1960 x 1897 pixels.
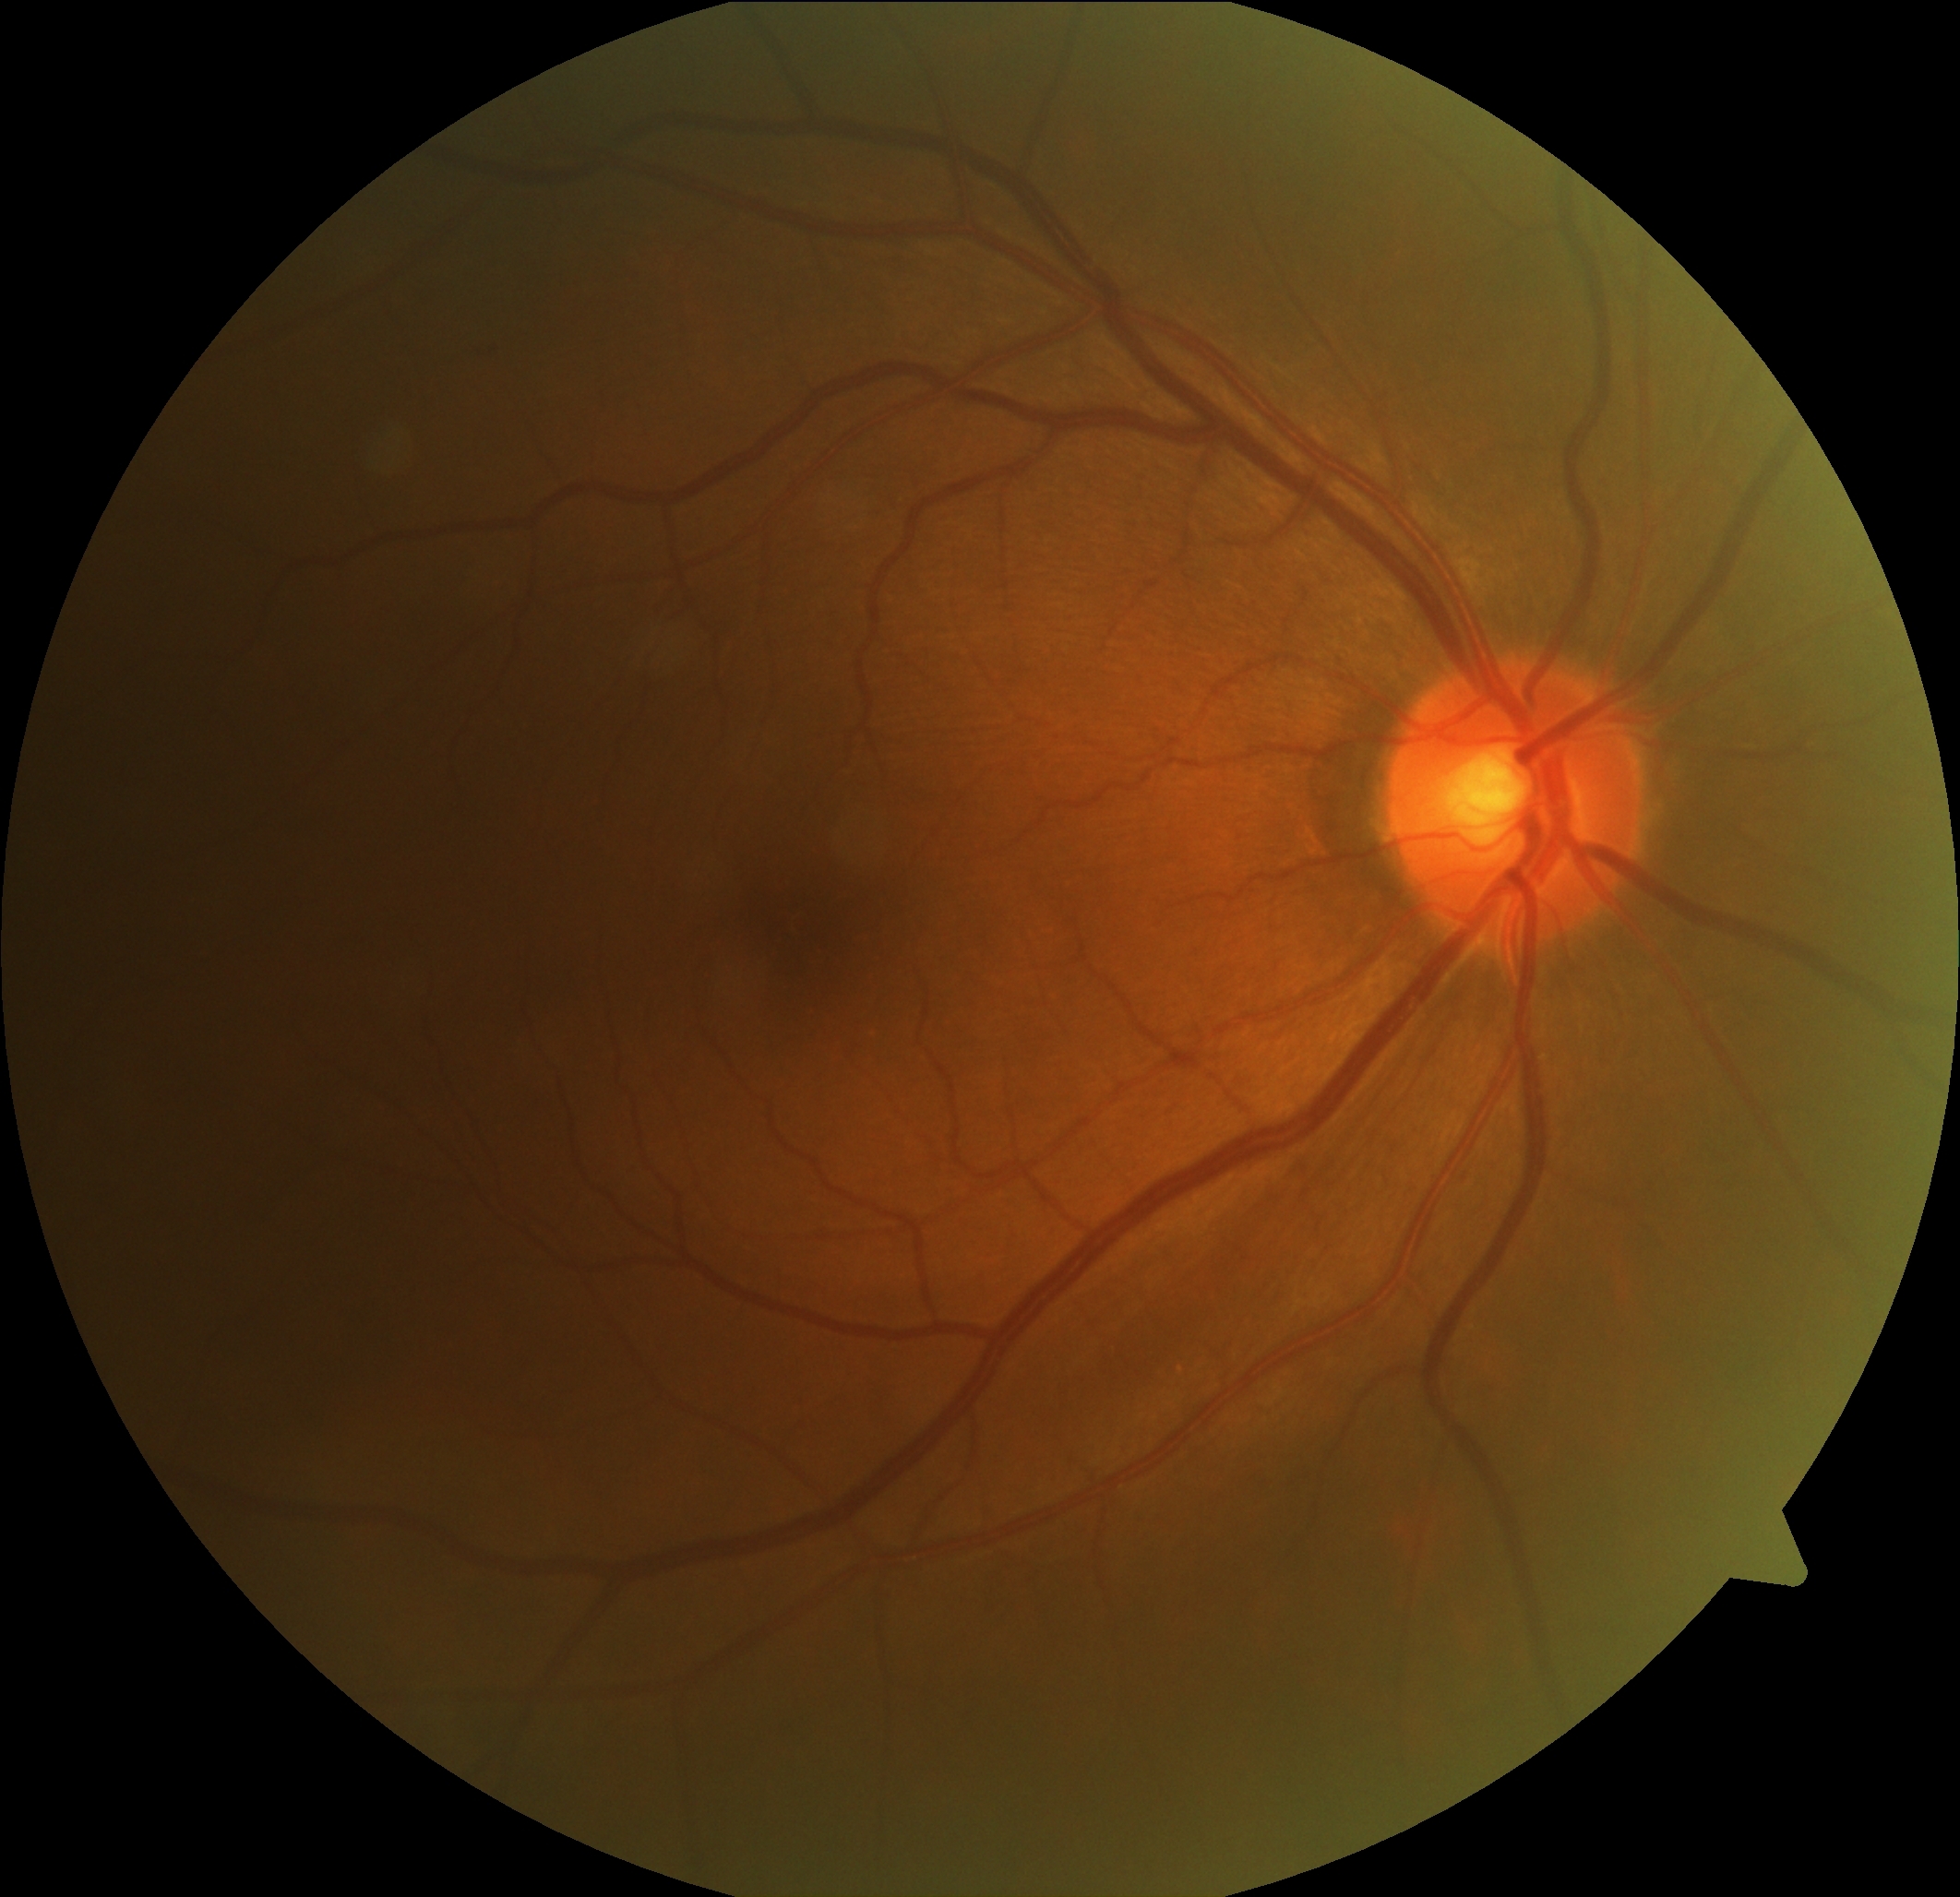 DR: grade 0 (no apparent retinopathy).